Phoenix ICON, 100° FOV. Phoenix ICON wide-field infant fundus image: 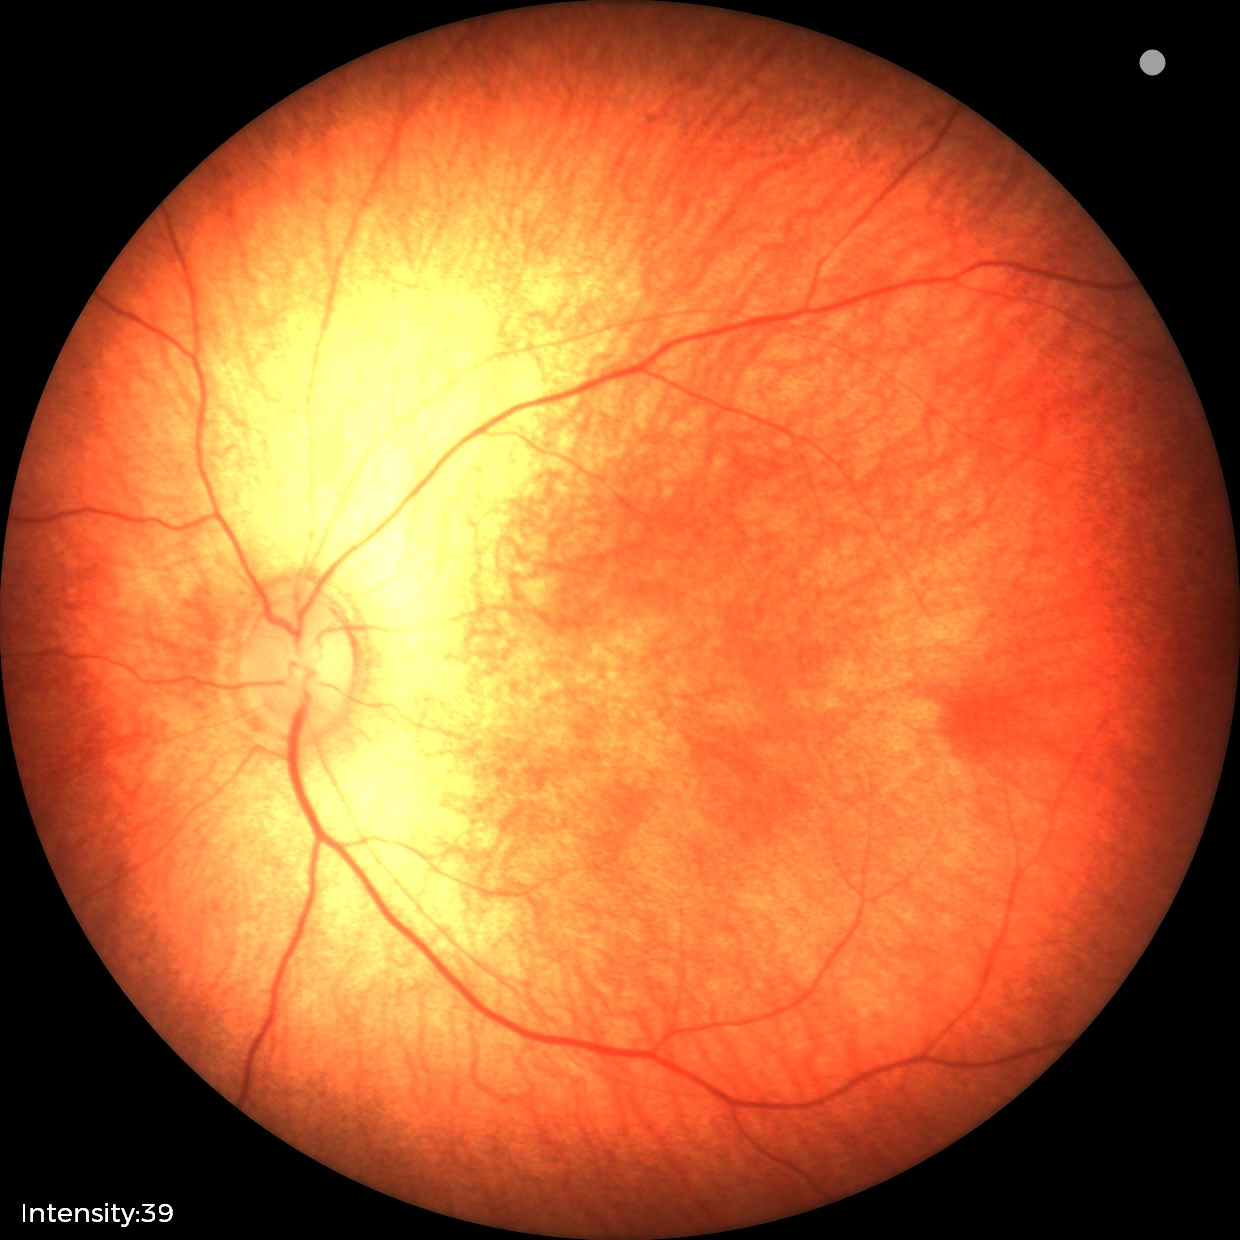
Q: What is the diagnosis from this examination?
A: physiological retinal finding